640x480. Pediatric retinal photograph (wide-field). Captured with the Clarity RetCam 3 (130° field of view)
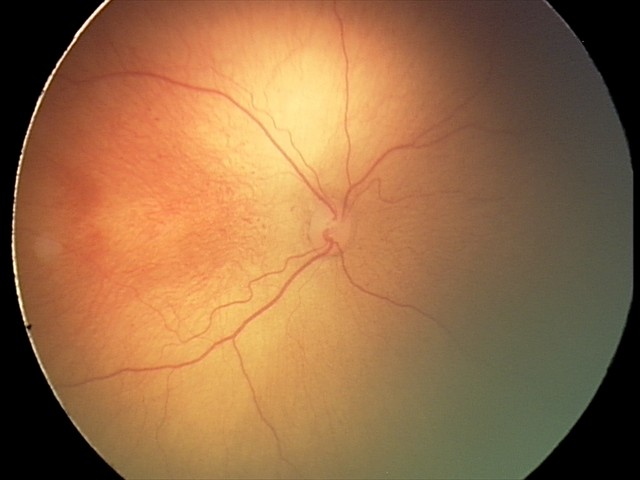 Screening examination consistent with retinopathy of prematurity (ROP) stage 2. Plus disease absent.